848 by 848 pixels:
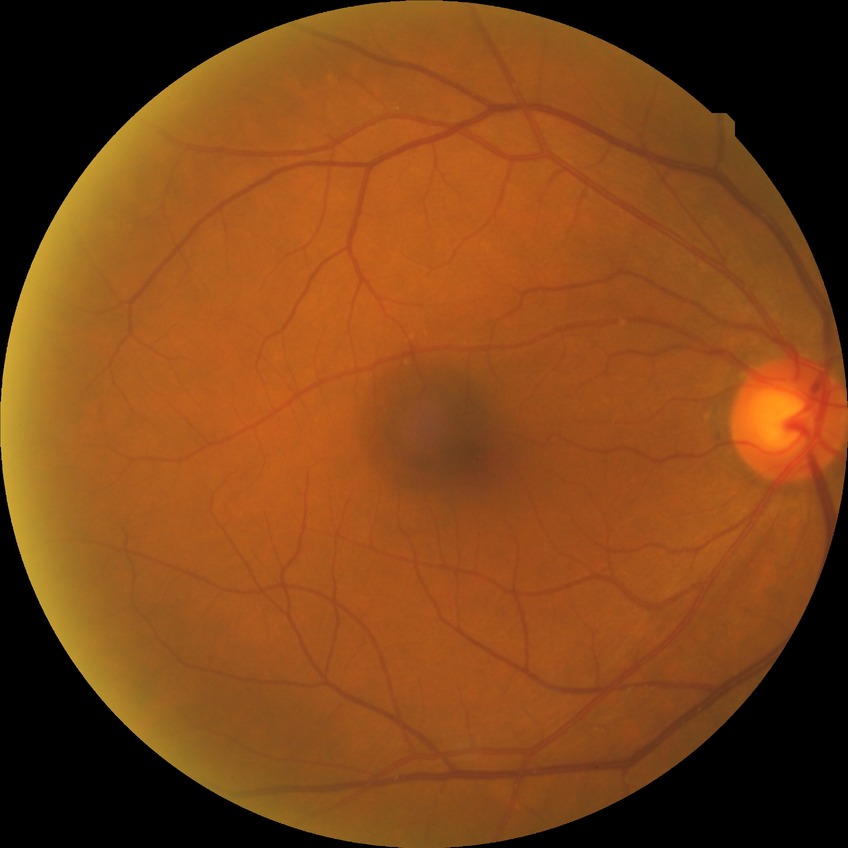
- diabetic retinopathy (DR) — no diabetic retinopathy (NDR)